Wide-field fundus image from infant ROP screening
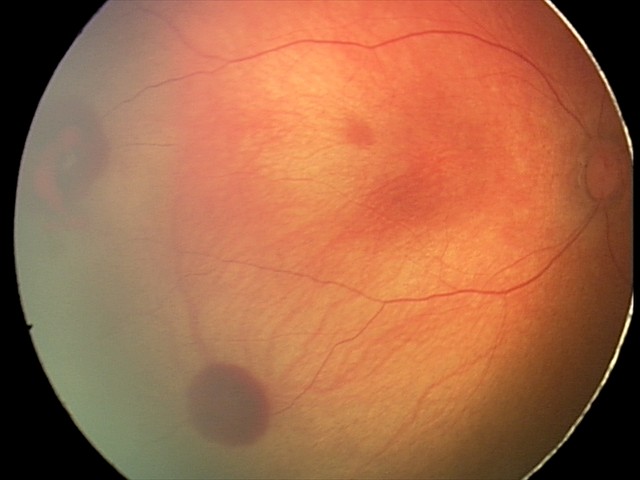
Diagnosis from this screening exam: retinal hemorrhages.